2352 by 1568 pixels. Retinal fundus photograph
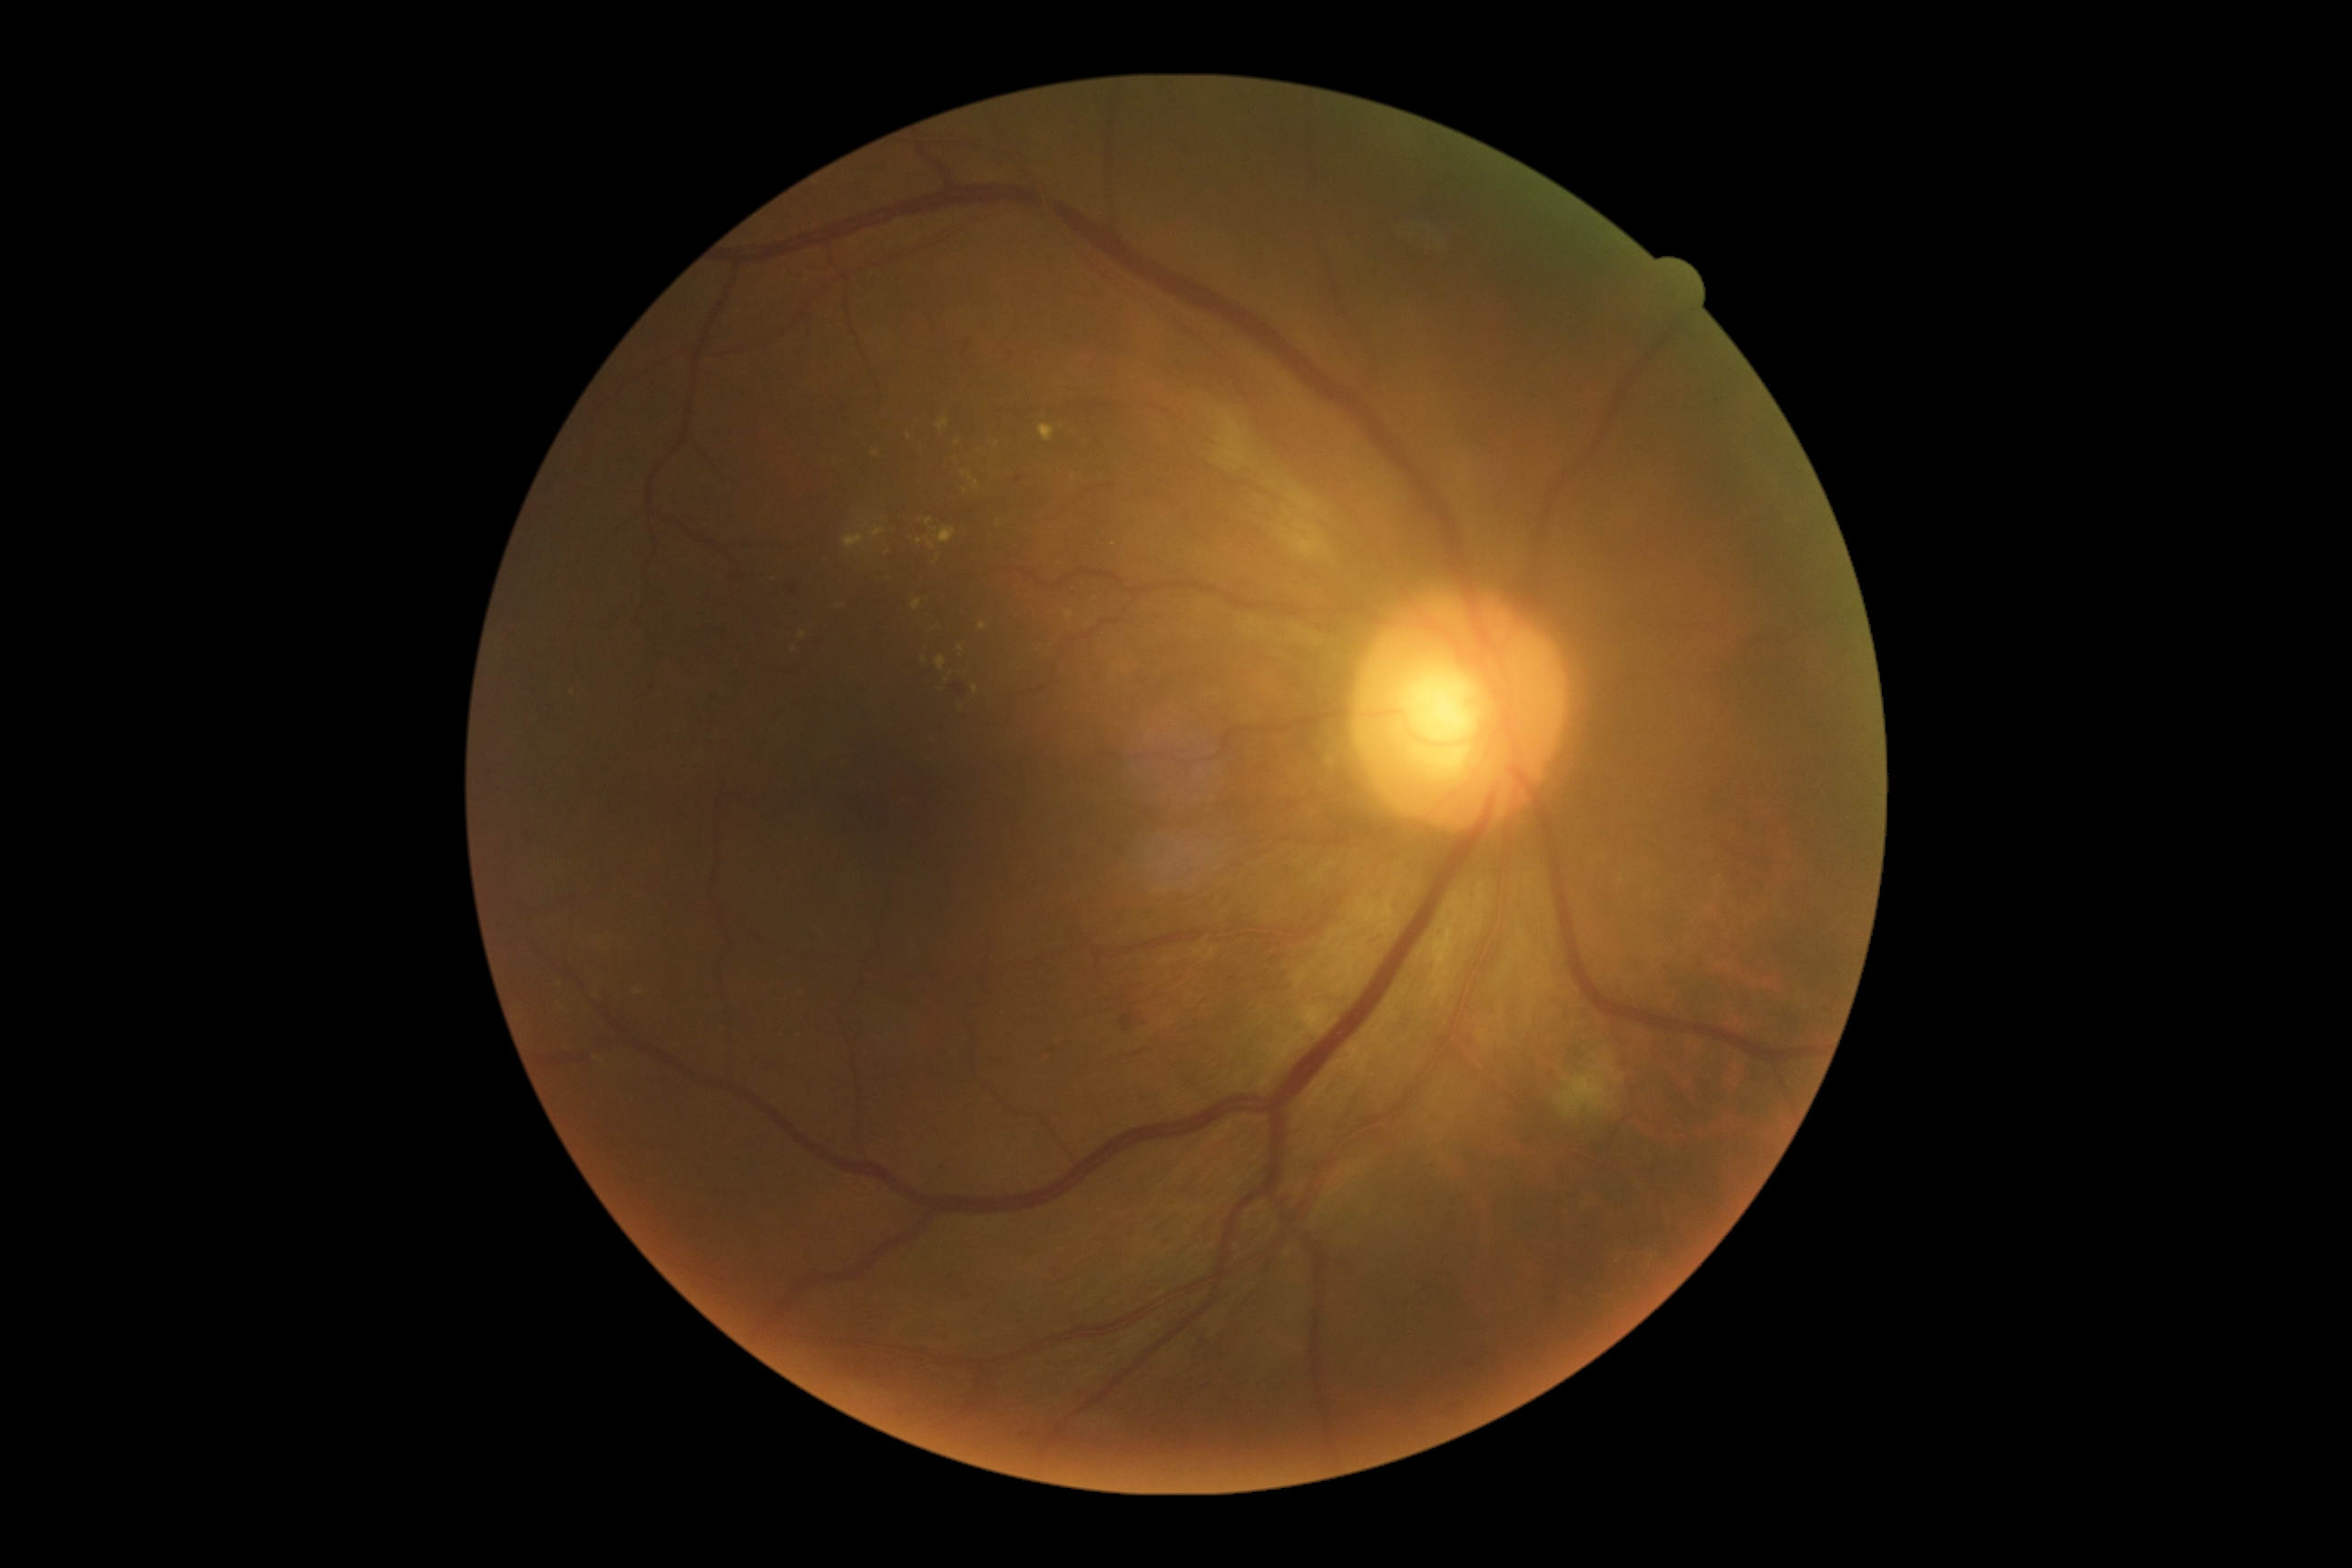
dr_grade: grade 2 — more than just microaneurysms but less than severe NPDR